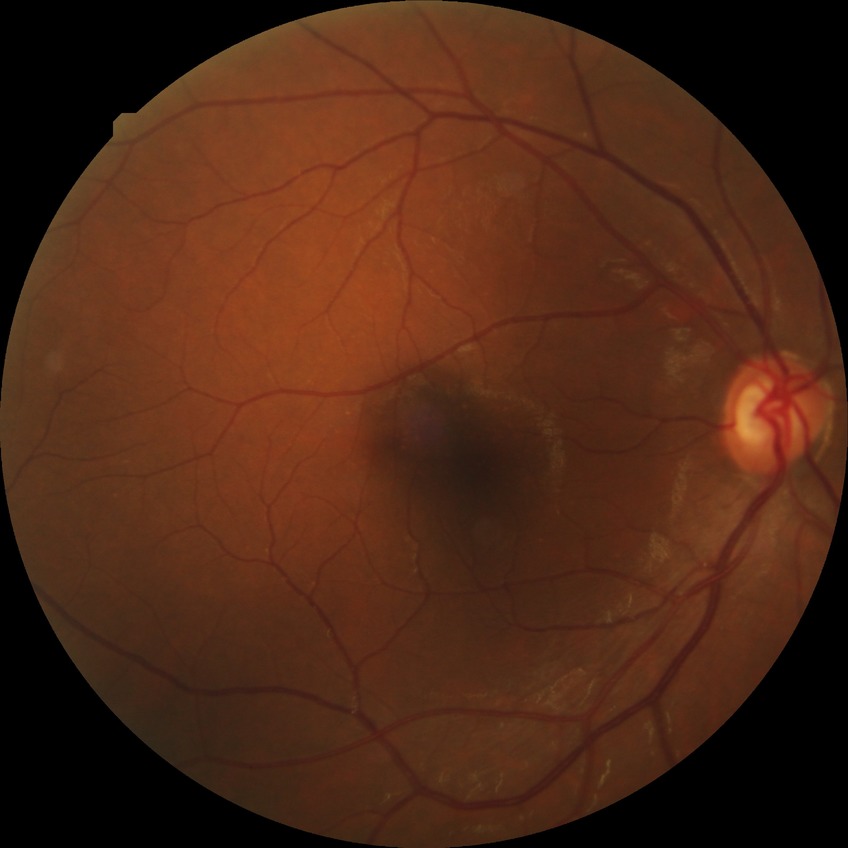
{"davis_grade": "no diabetic retinopathy"}